NIDEK AFC-230 — 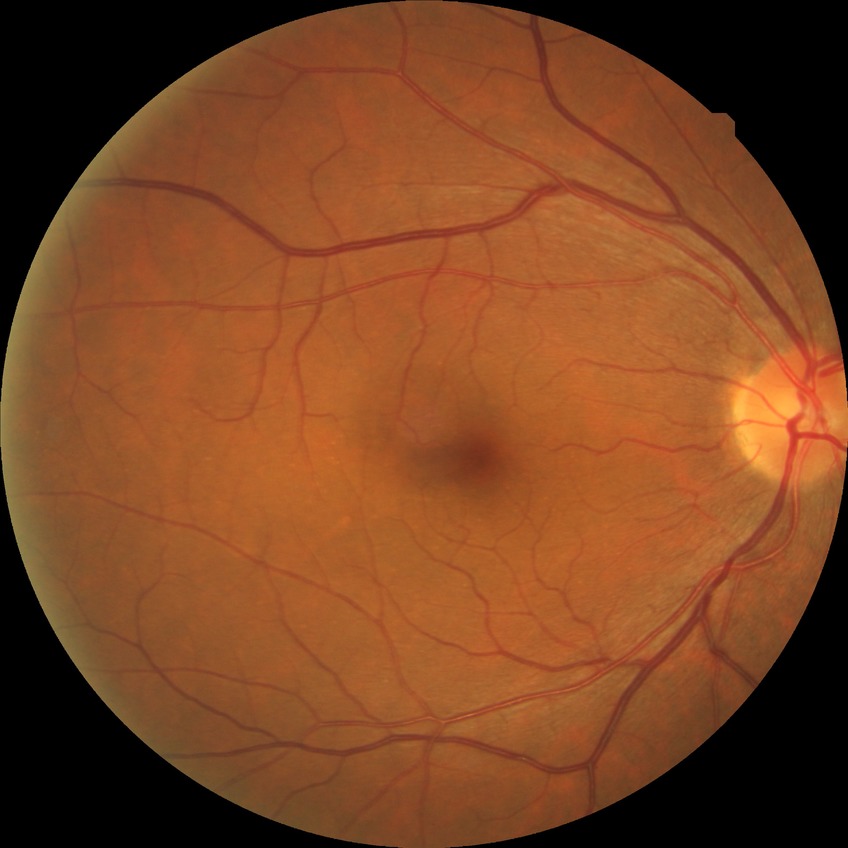
Modified Davis classification is no diabetic retinopathy.